848 by 848 pixels, color fundus image
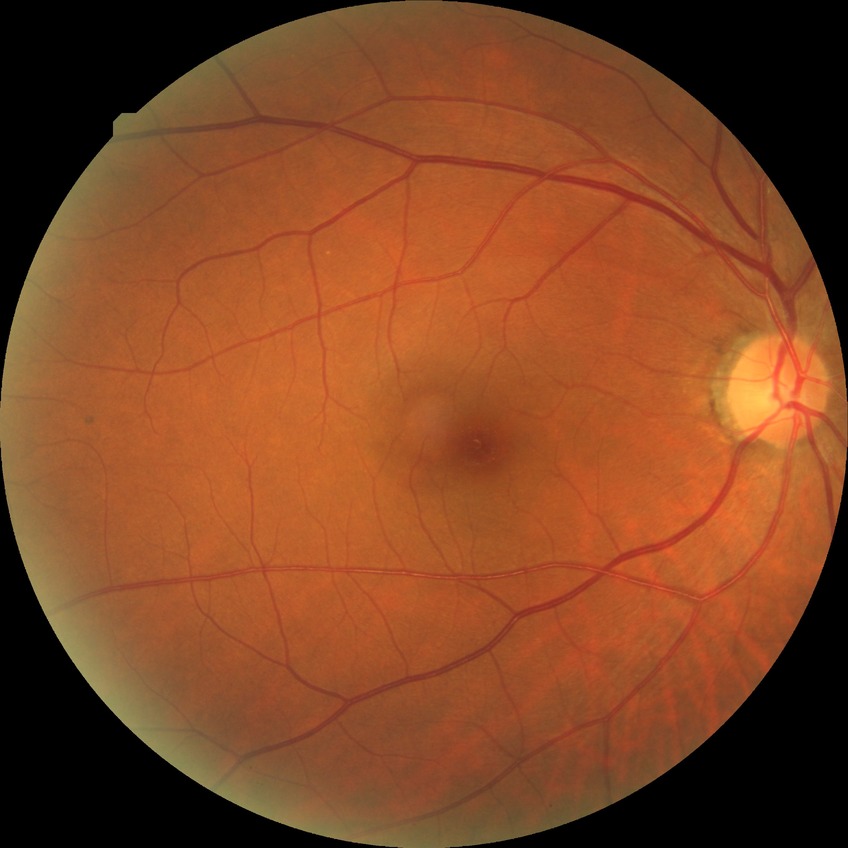 Diabetic retinopathy (DR) is SDR (simple diabetic retinopathy).